Phoenix ICON, 100° FOV. 1240 x 1240 pixels. Phoenix ICON wide-field infant fundus image — 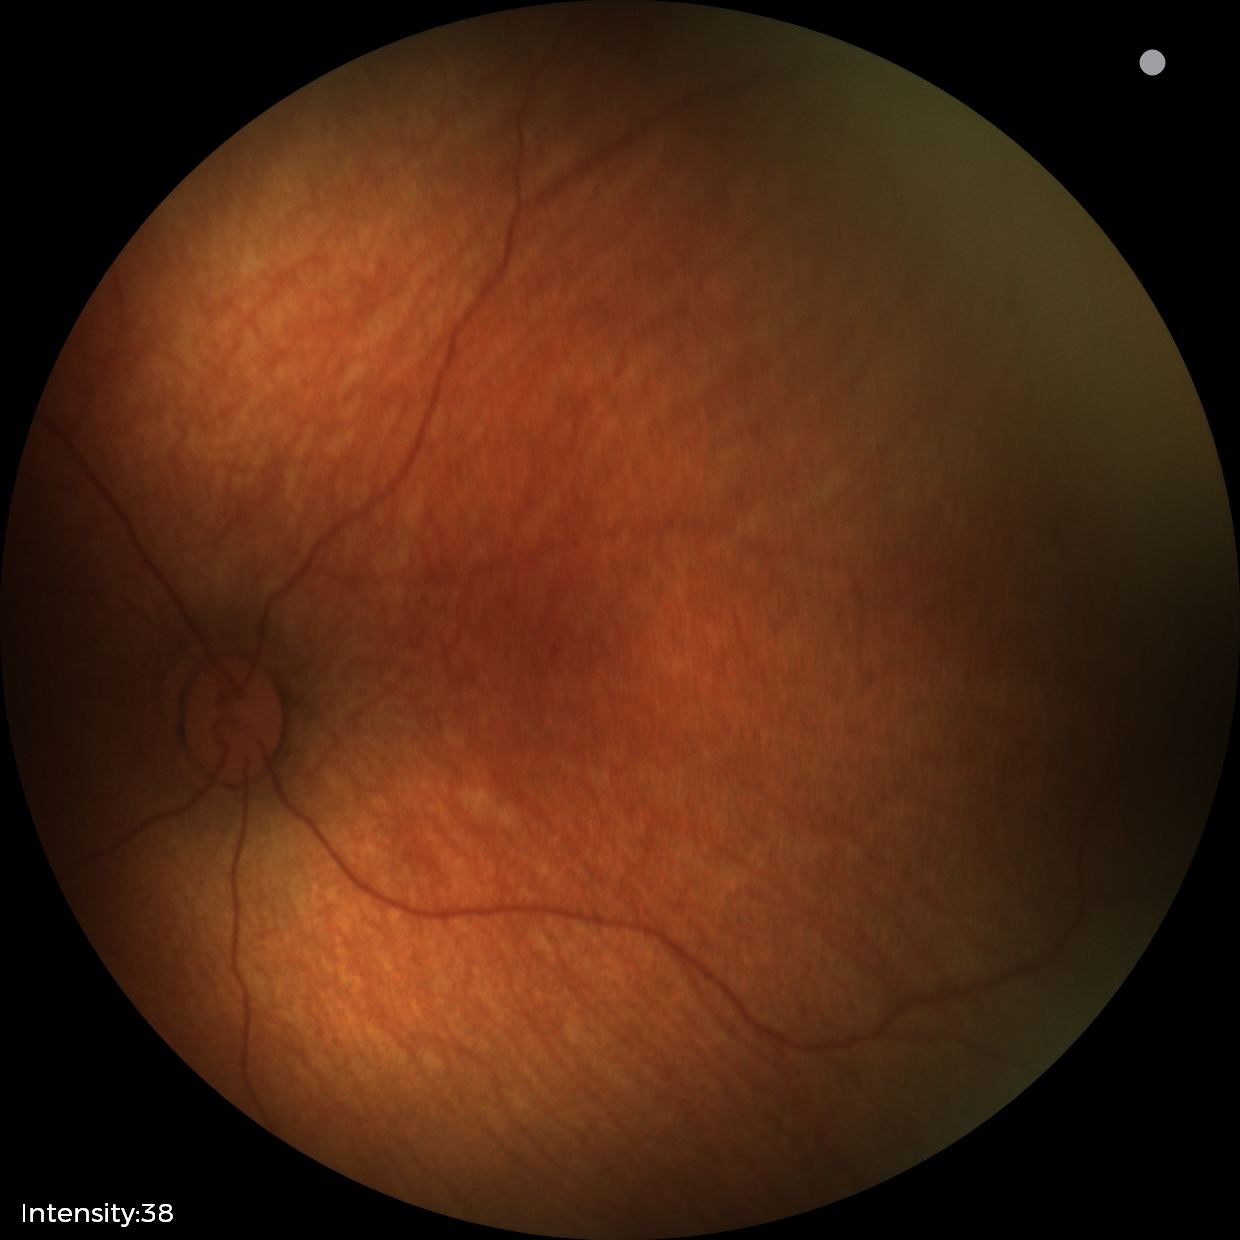 Impression: physiological retinal finding.